Wide-field contact fundus photograph of an infant. Acquired on the Clarity RetCam 3
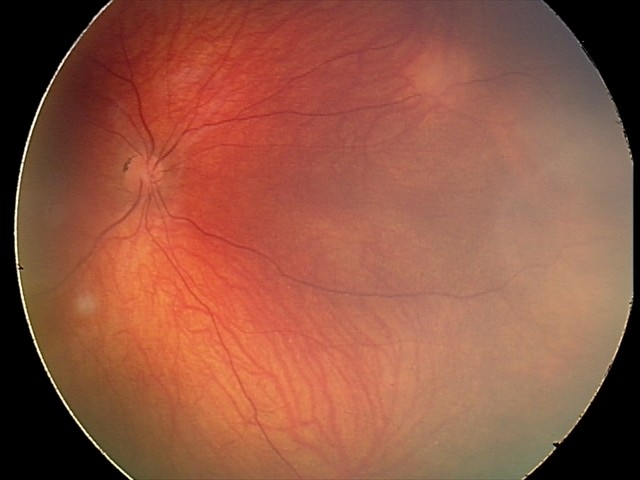
Diagnosis from this screening exam: retinal astrocytic hamartoma.